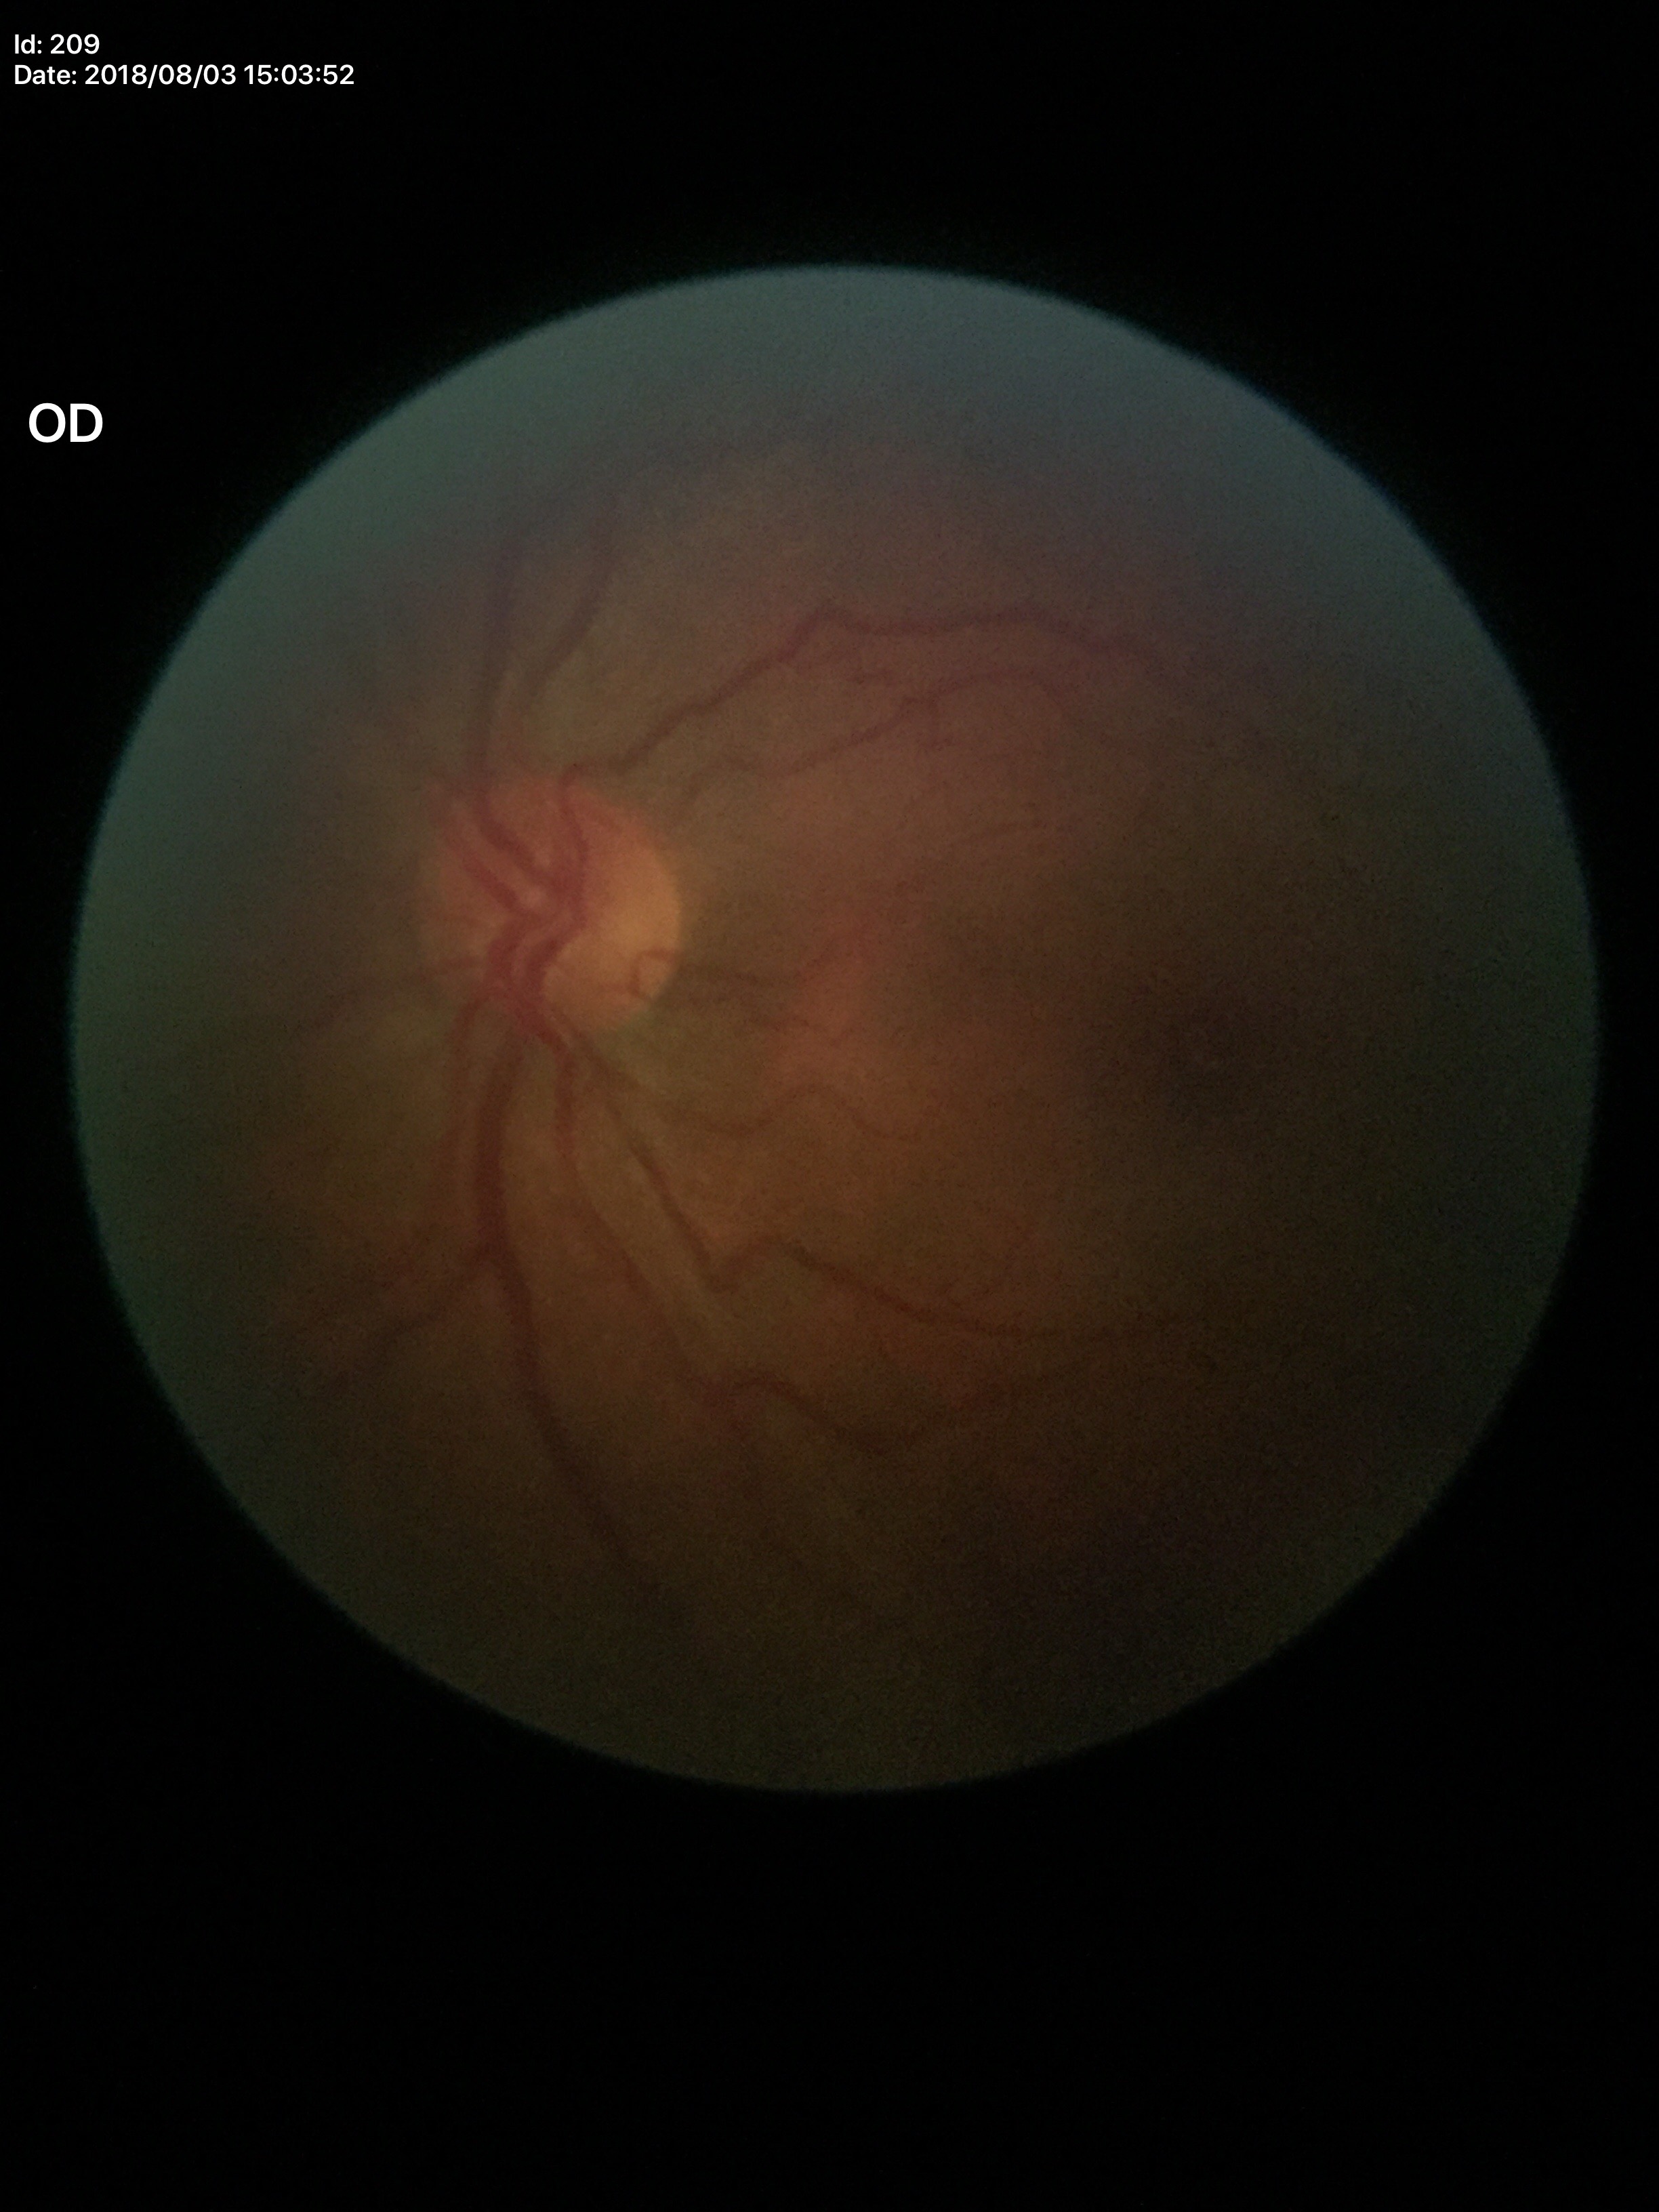 Q: Horizontal CDR?
A: 0.43
Q: What is the vertical cup-to-disc ratio?
A: 0.38
Q: Is there glaucoma suspicion?
A: no suspicious findings